45-degree field of view. Fundus photo
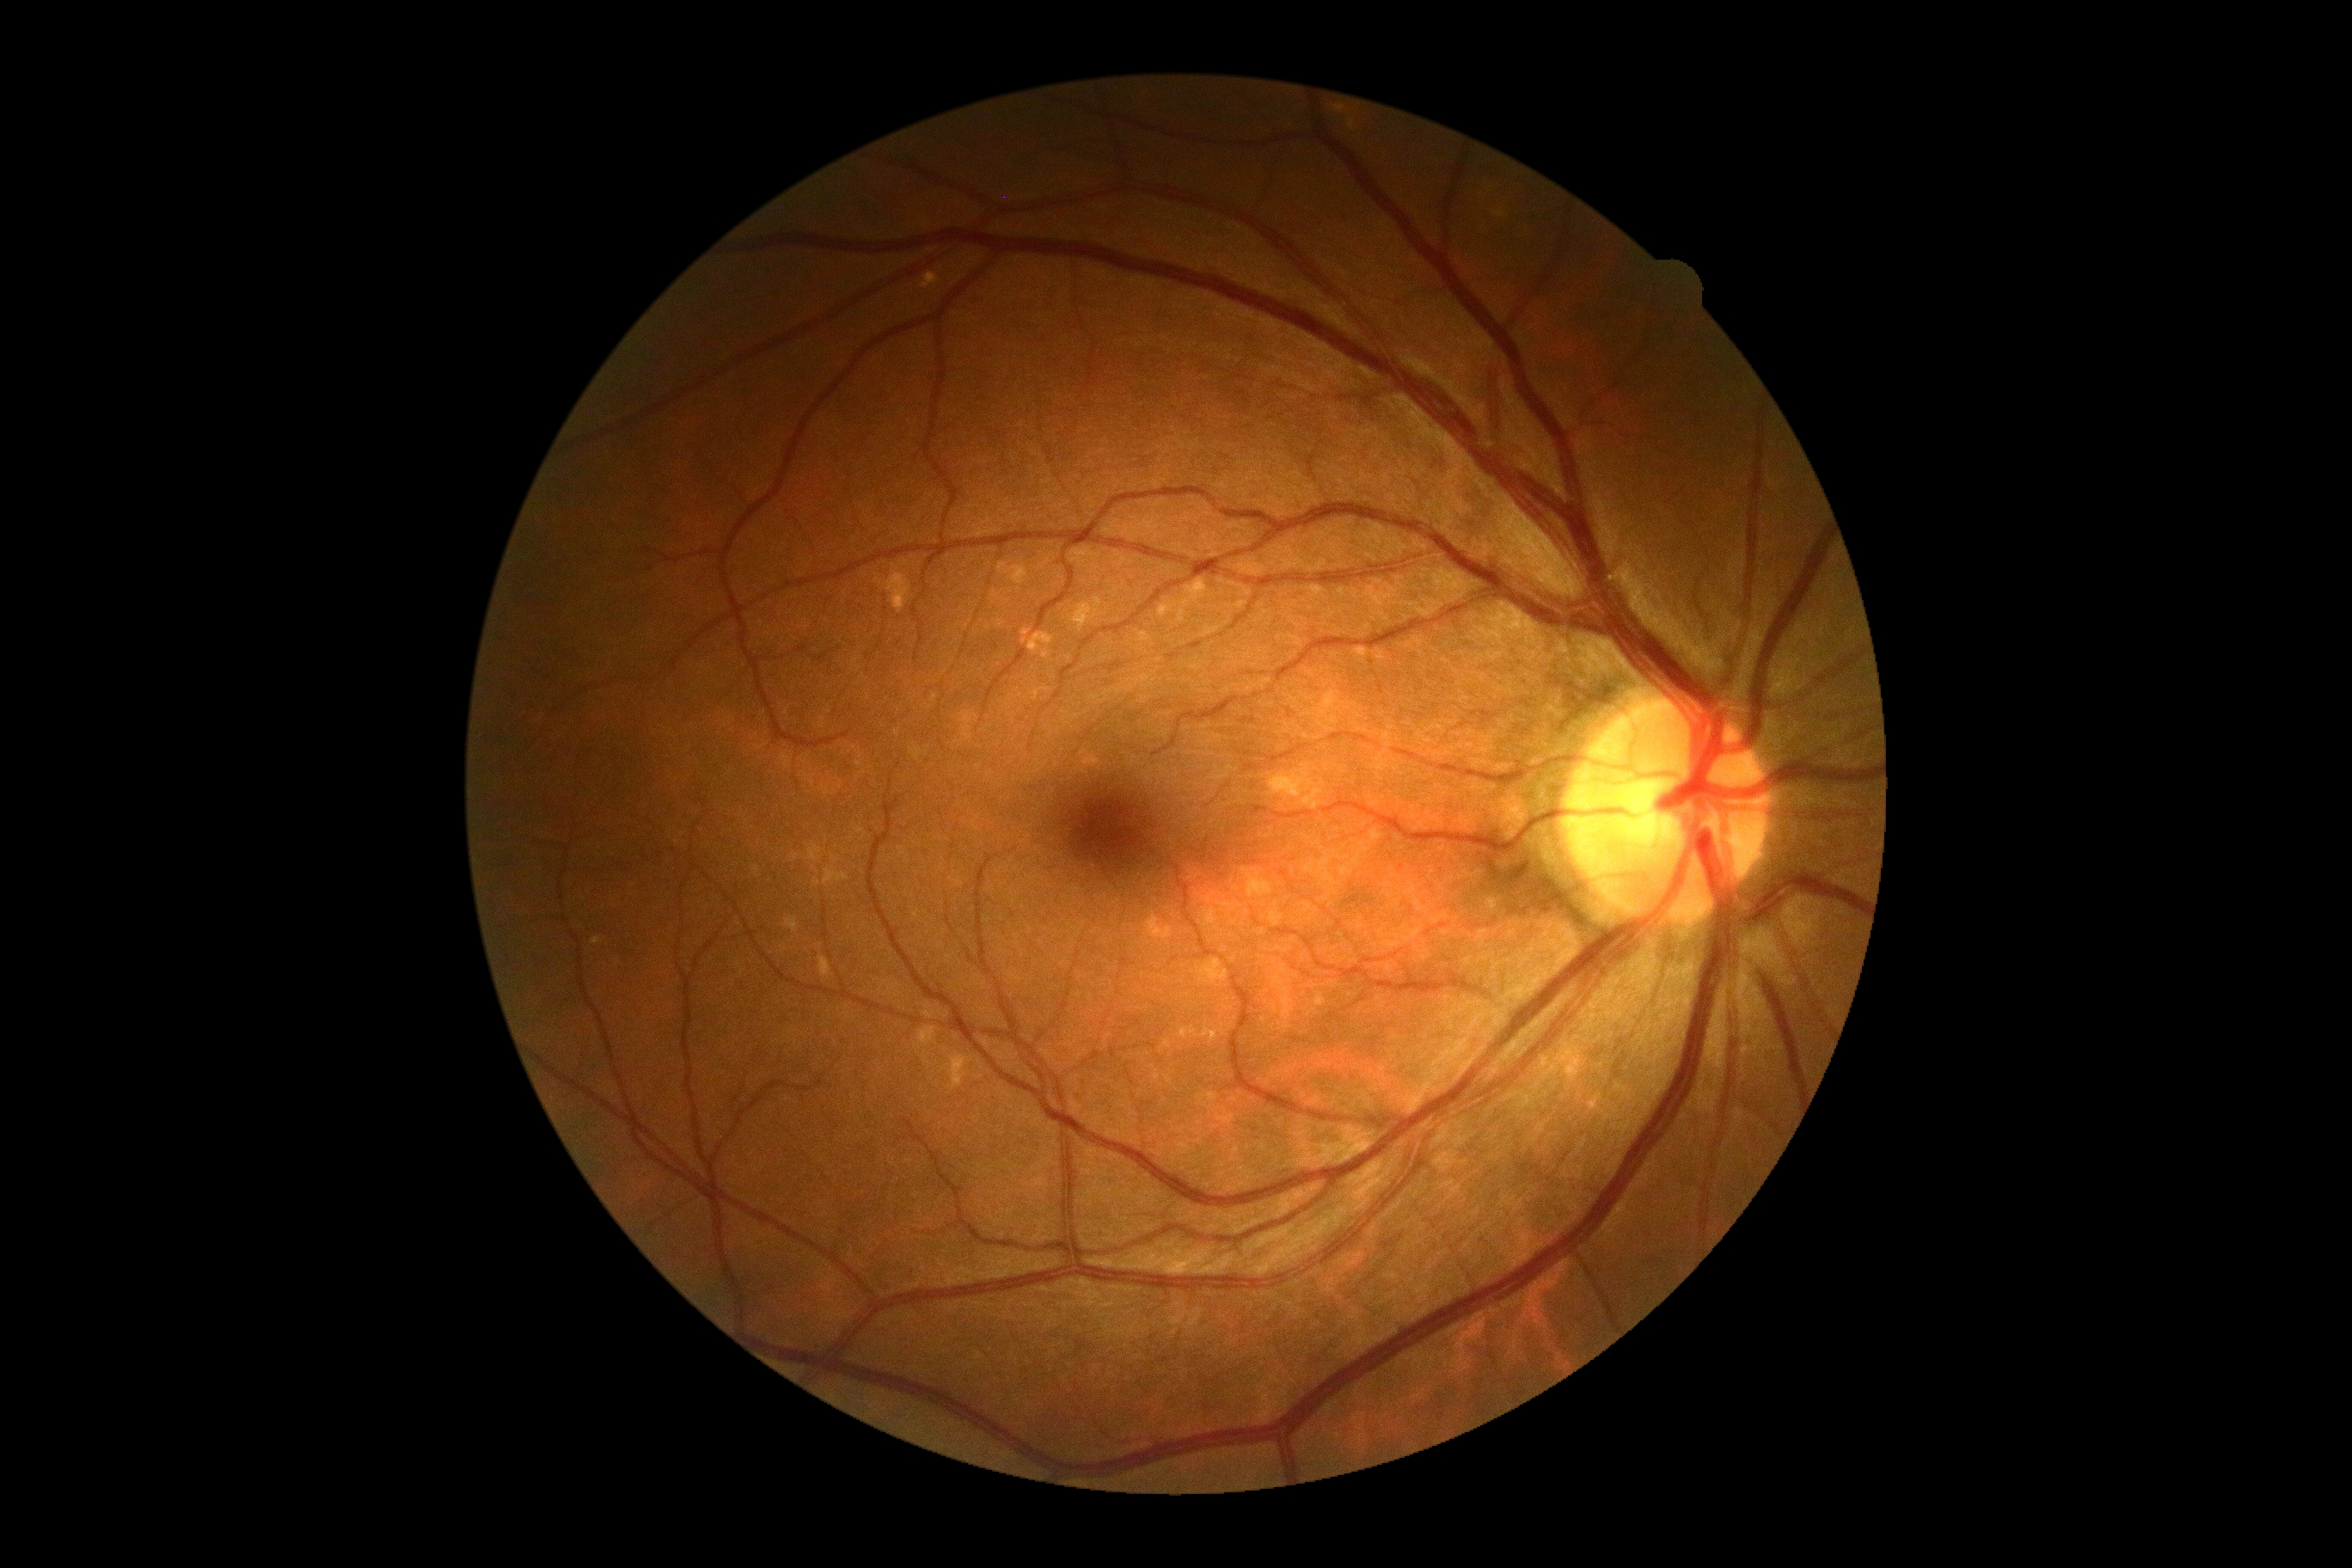
DR grade is no apparent retinopathy (0) — no visible signs of diabetic retinopathy. No DR findings.